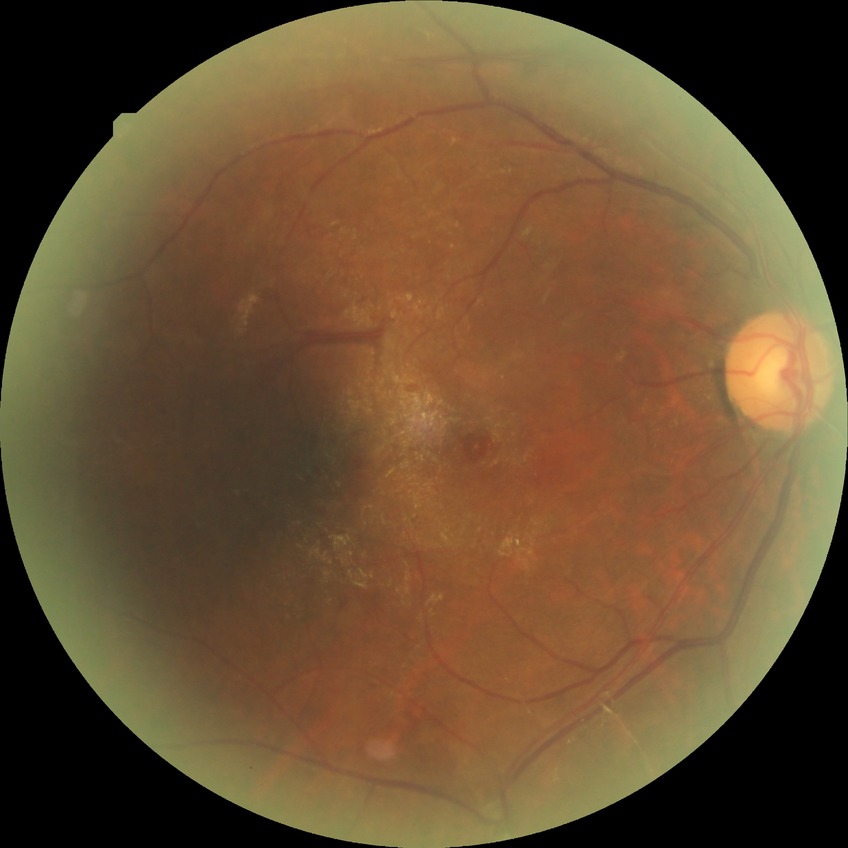 Diabetic retinopathy stage: proliferative diabetic retinopathy.